Retinal fundus photograph. 2352 by 1568 pixels: 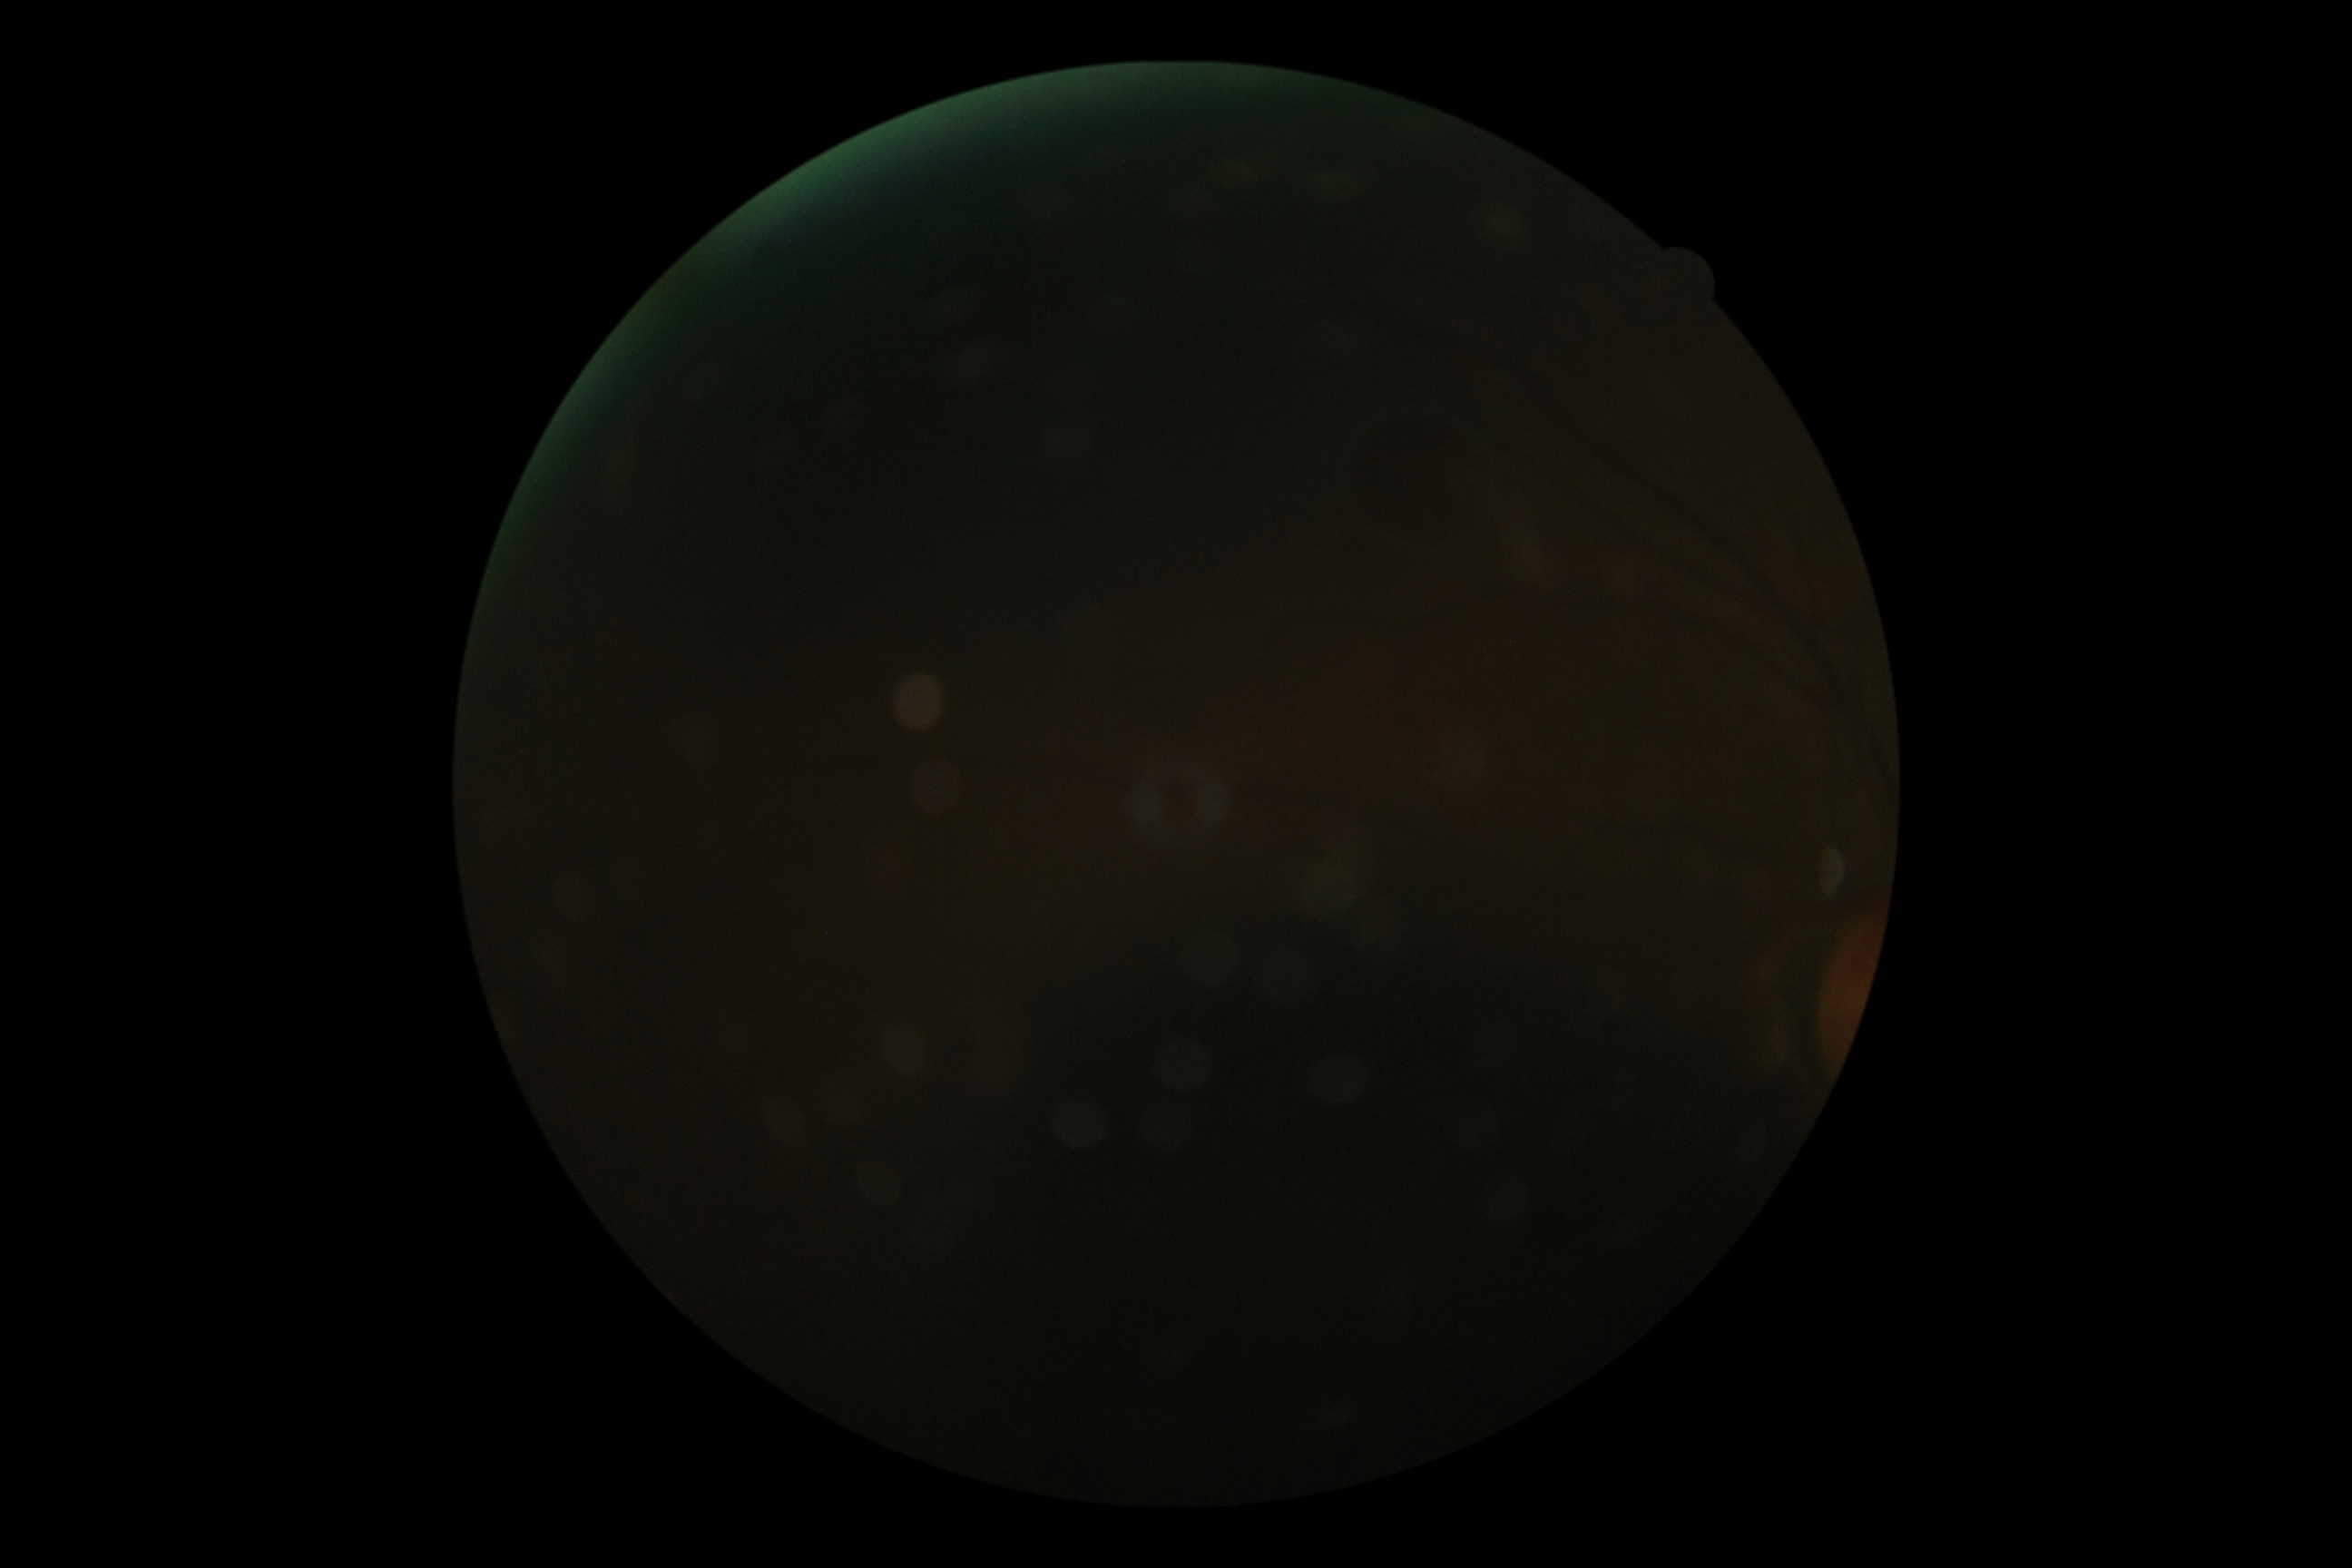
{"dr_grade": "ungradable"}